240 by 240 pixels, non-mydriatic:
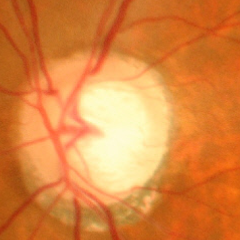

Glaucomatous optic neuropathy is present. Glaucoma assessment = severe glaucomatous damage.